Nonmydriatic, CFP.
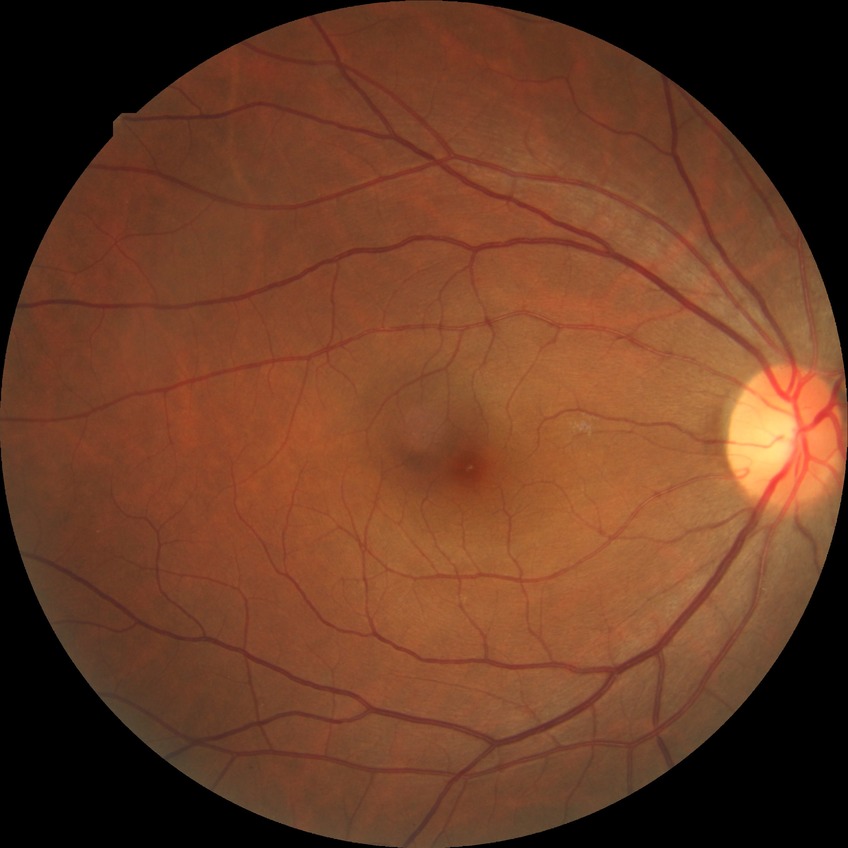
Diabetic retinopathy stage: no diabetic retinopathy.